Pediatric retinal photograph (wide-field)
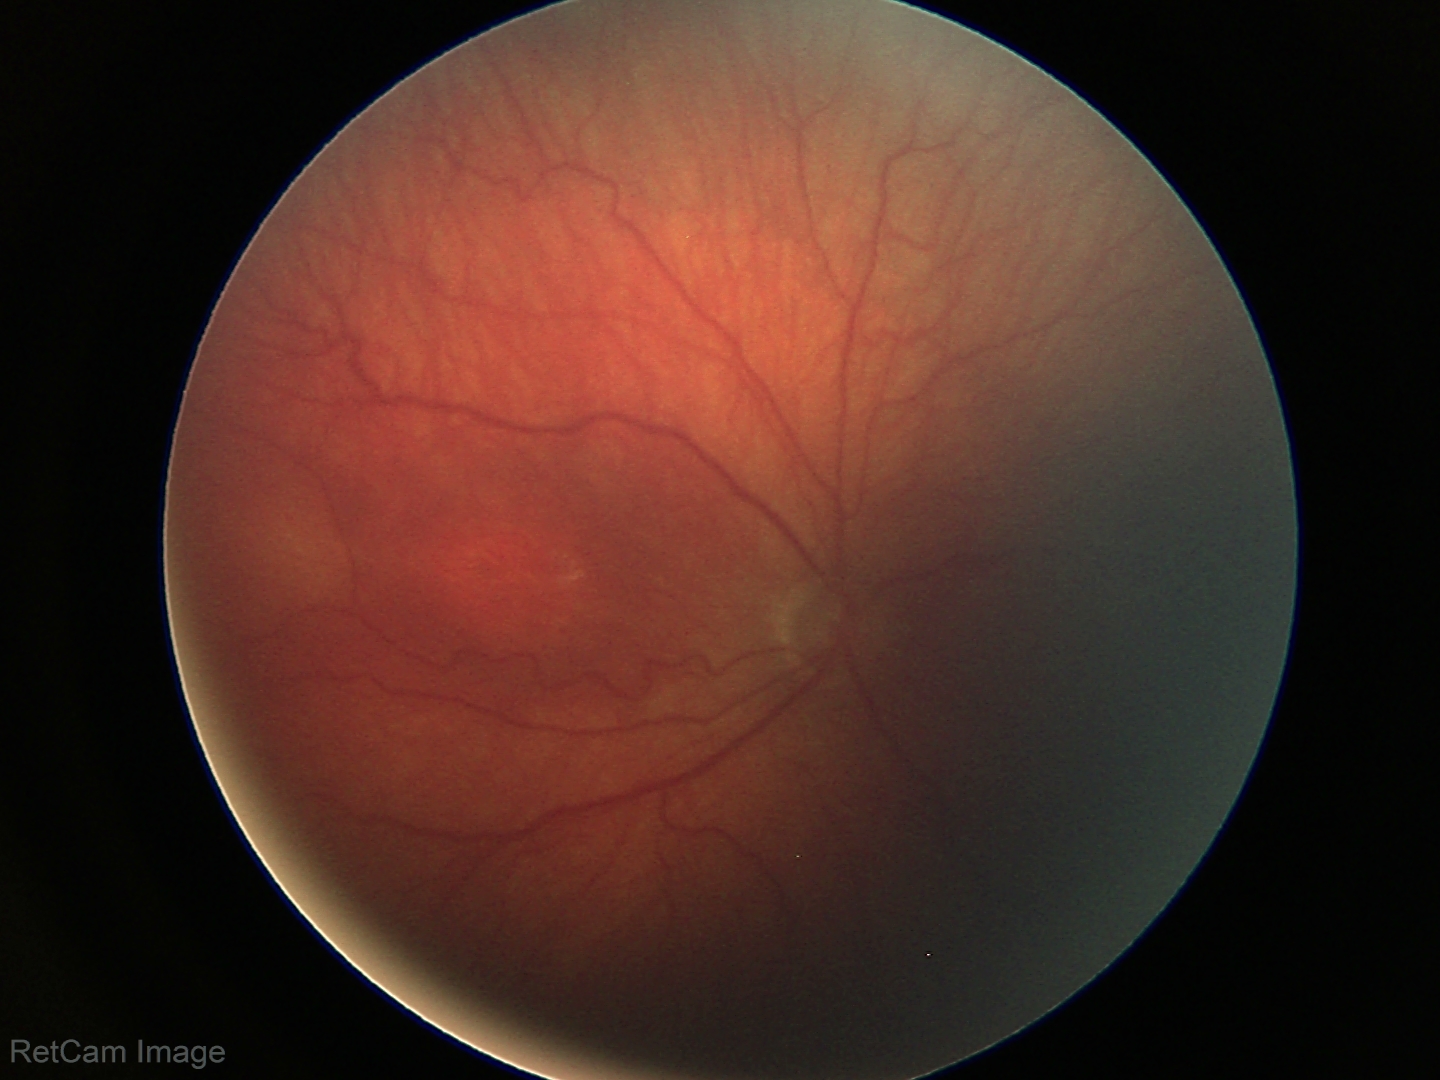

Screening series with retinopathy of prematurity stage 3.